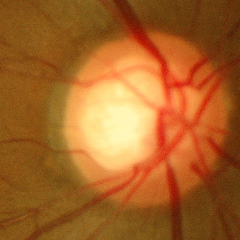
Findings consistent with no glaucomatous changes.